45-degree field of view. CFP — 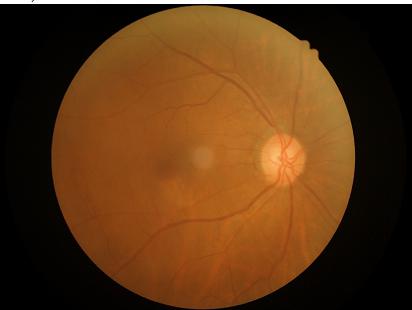

Image quality assessment: contrast: adequate | sharpness: clear | overall: acceptable | illumination: adequate.